Macula-centered · color fundus photograph · captured after pupil dilation
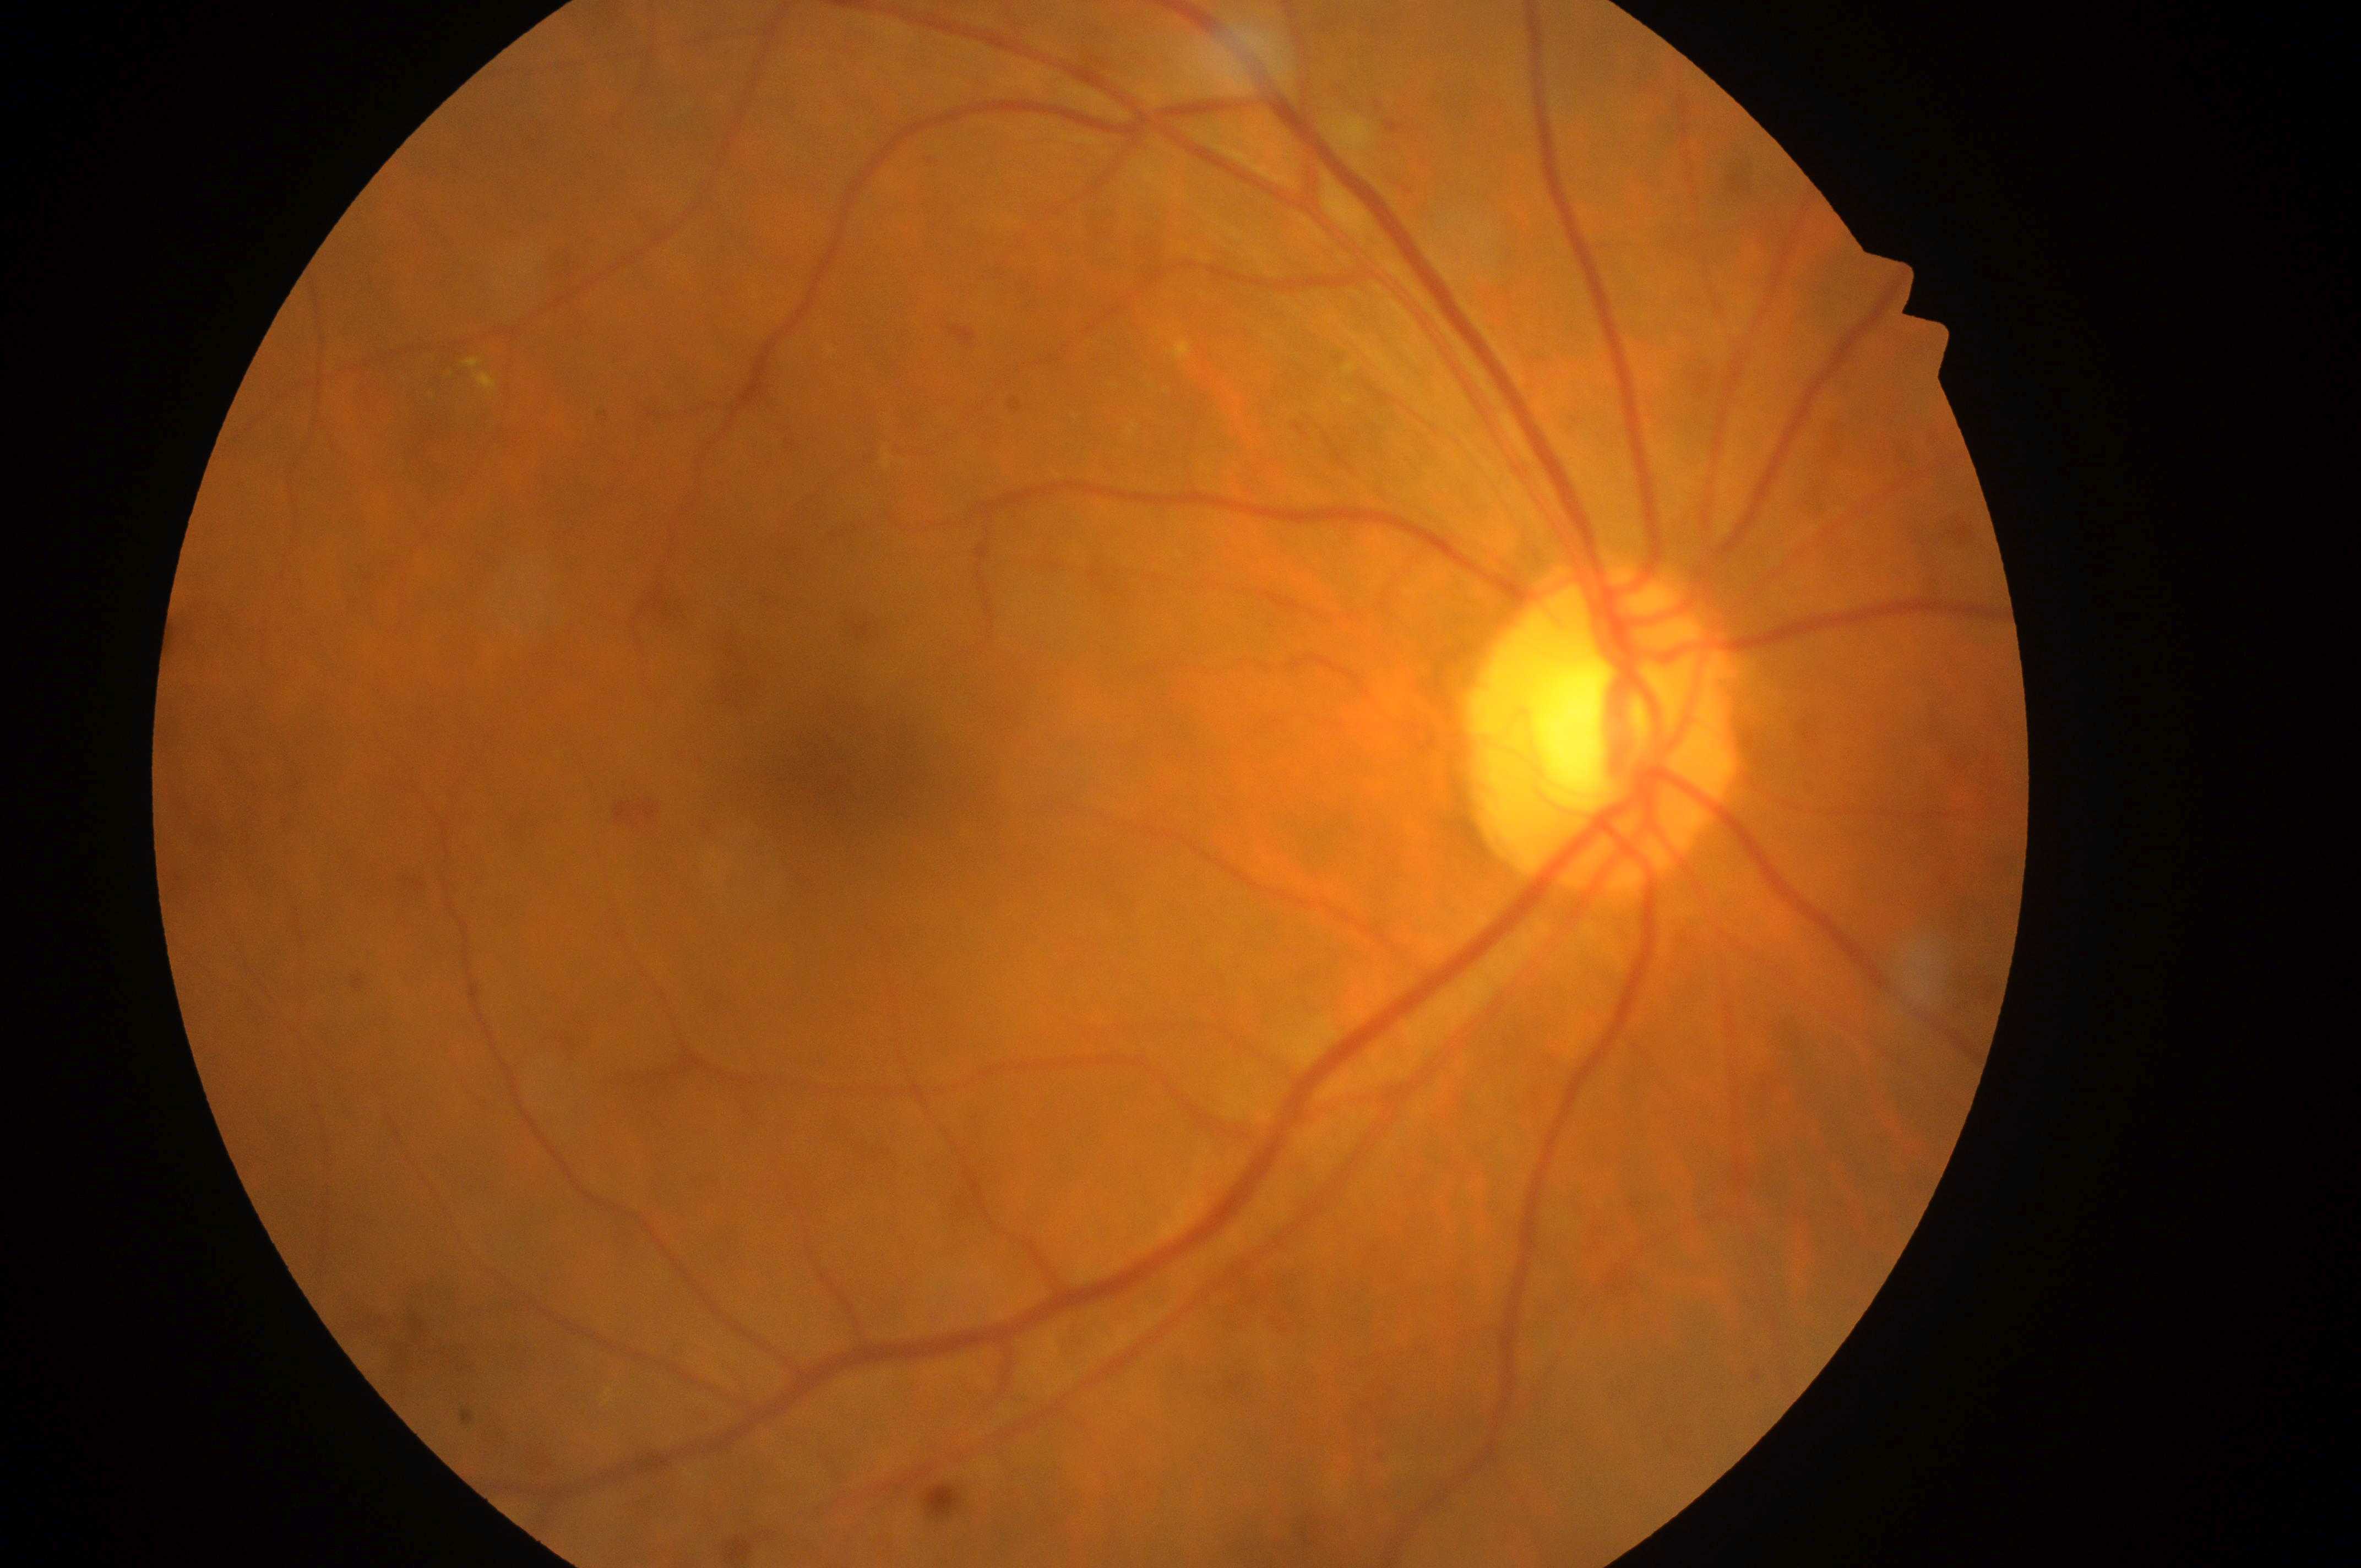

laterality: oculus dexter | fovea centralis: 864, 769 | diabetic retinopathy severity: moderate non-proliferative diabetic retinopathy (grade 2) — more than just microaneurysms but less than severe NPDR | macular edema risk: low risk (grade 1) — hard exudates present, but outside one disc diameter of the macula center | ONH: 1592, 748.